997x997px, color fundus photograph centered on the optic disc
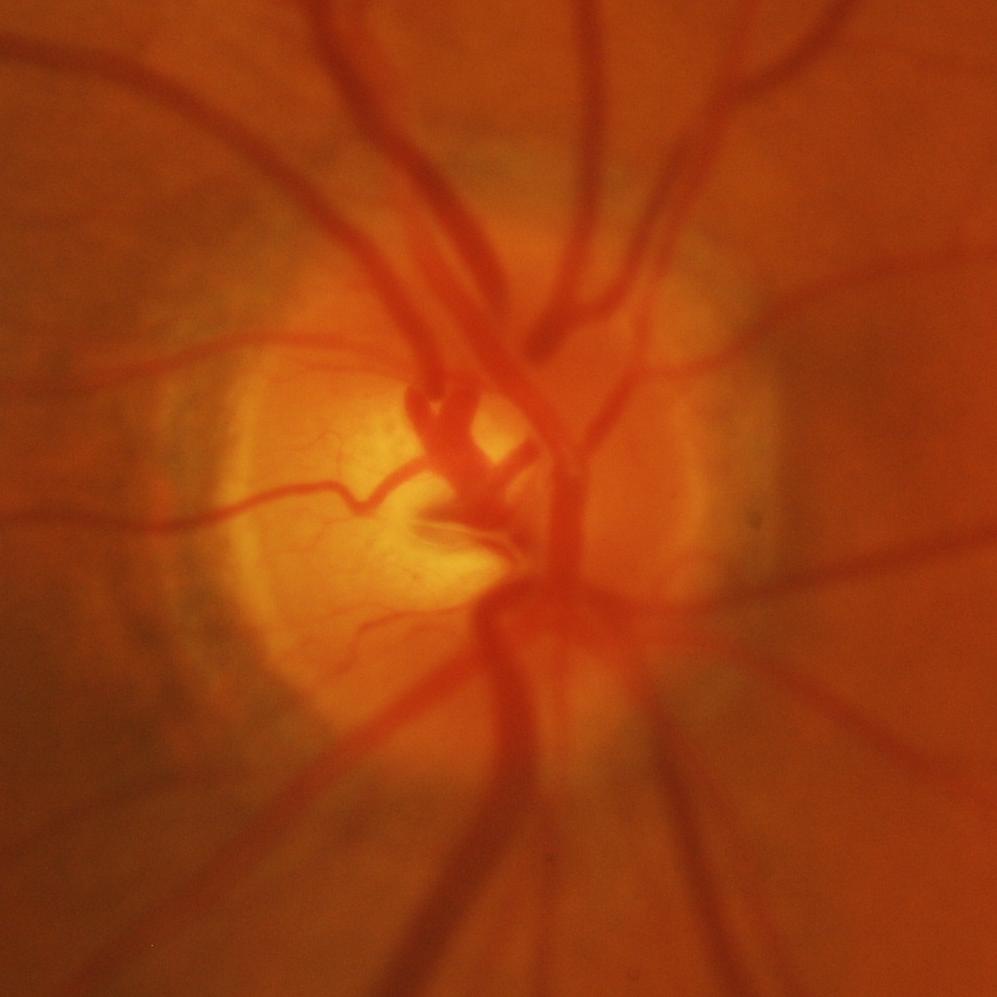 Optic disc appearance consistent with glaucoma.